848x848px
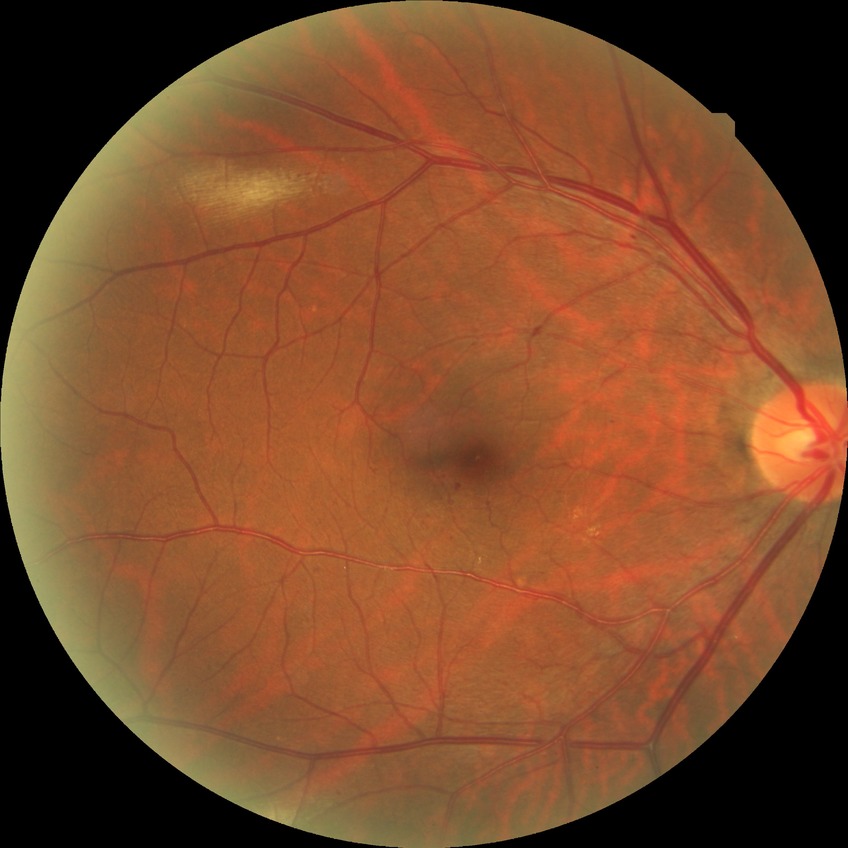
{"davis_grade": "no diabetic retinopathy"}